Pediatric retinal photograph (wide-field):
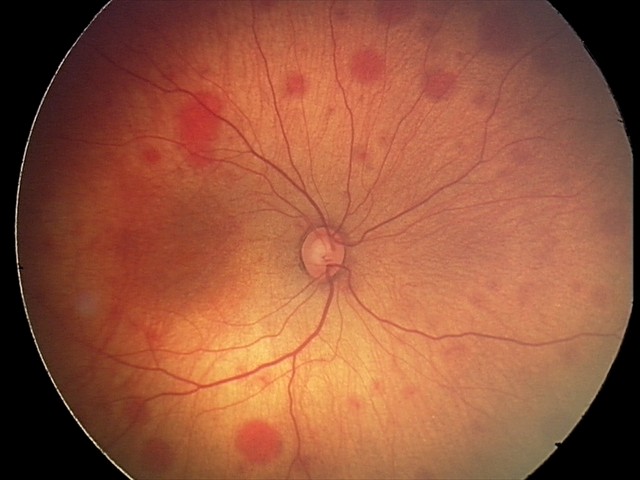 Screening diagnosis: retinal hemorrhages.